45° FOV.
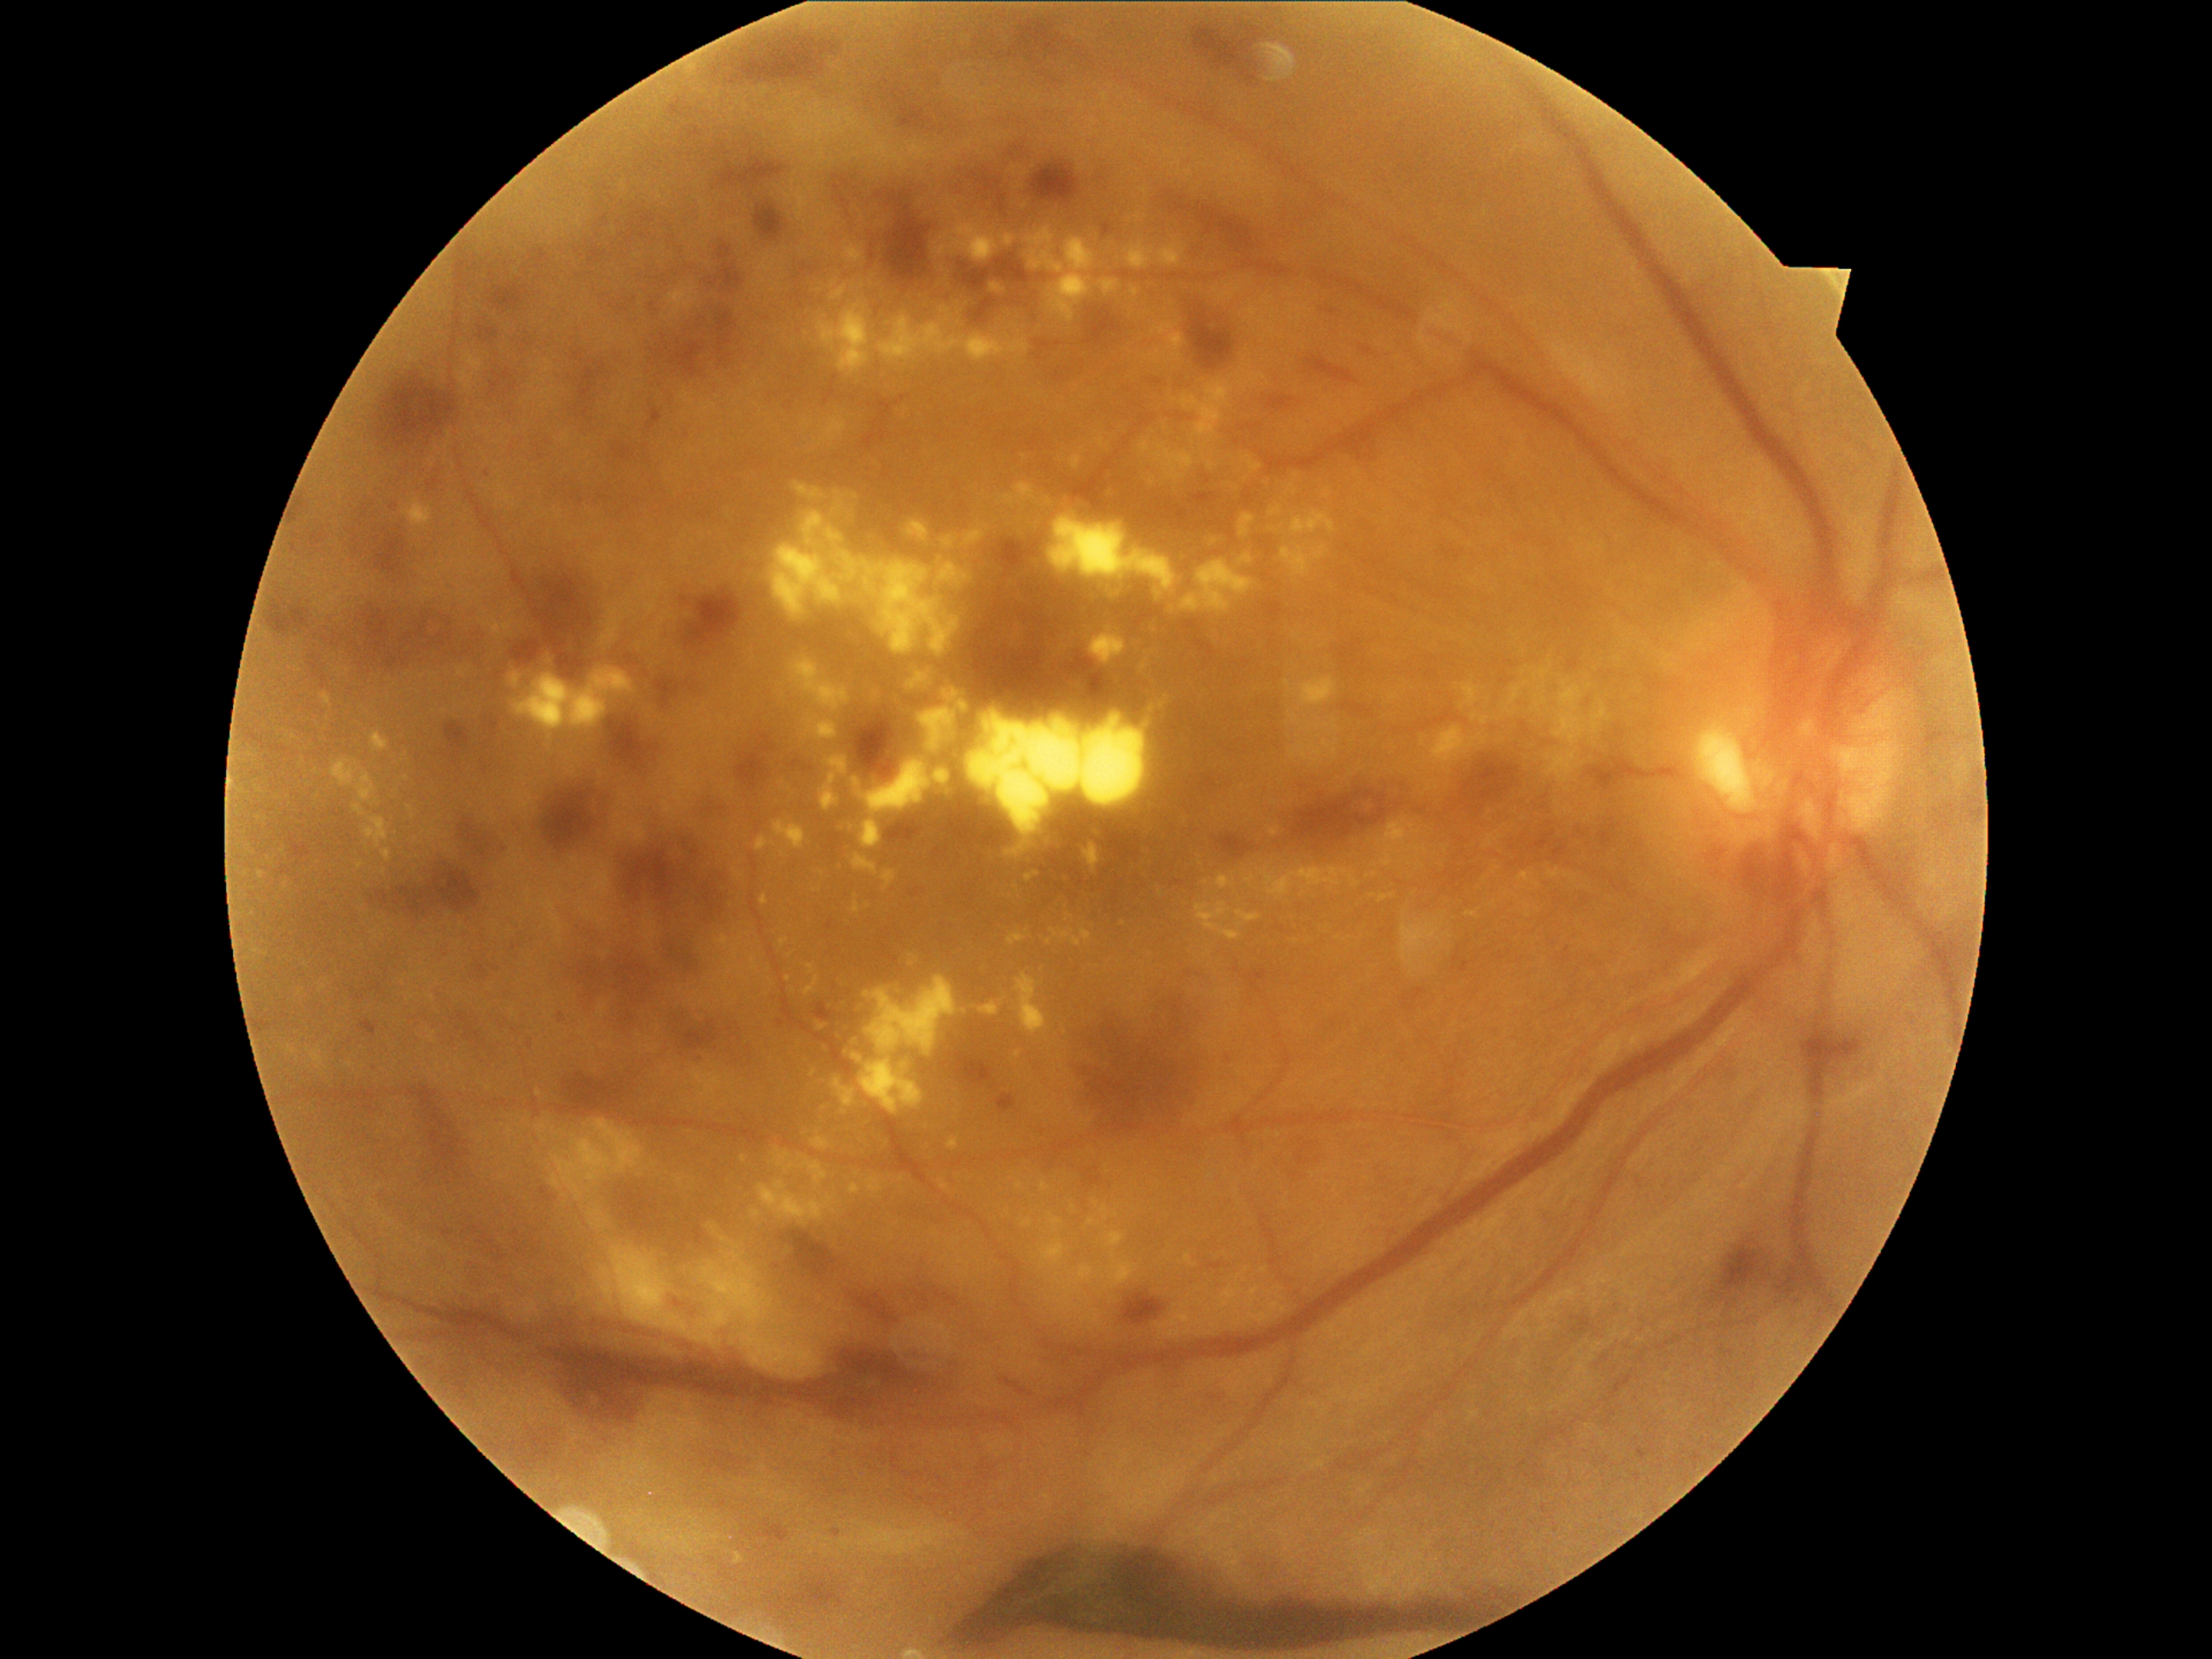
Diabetic retinopathy (DR) is 4
A subset of detected lesions:
hard exudates (EXs) (continued): 1247, 457, 1262, 474; 463, 352, 484, 373; 460, 370, 475, 390; 1016, 1051, 1022, 1059; 1044, 929, 1081, 948; 1097, 439, 1103, 448; 1433, 726, 1486, 764; 1291, 511, 1336, 537; 1004, 496, 1015, 506; 817, 1022, 827, 1030; 1151, 349, 1163, 361; 1438, 934, 1452, 948; 858, 760, 931, 849
EXs (small, approximate centers) near point(1208, 444); point(844, 1112); point(1306, 427); point(1419, 864); point(316, 772); point(1139, 217); point(1069, 1307)